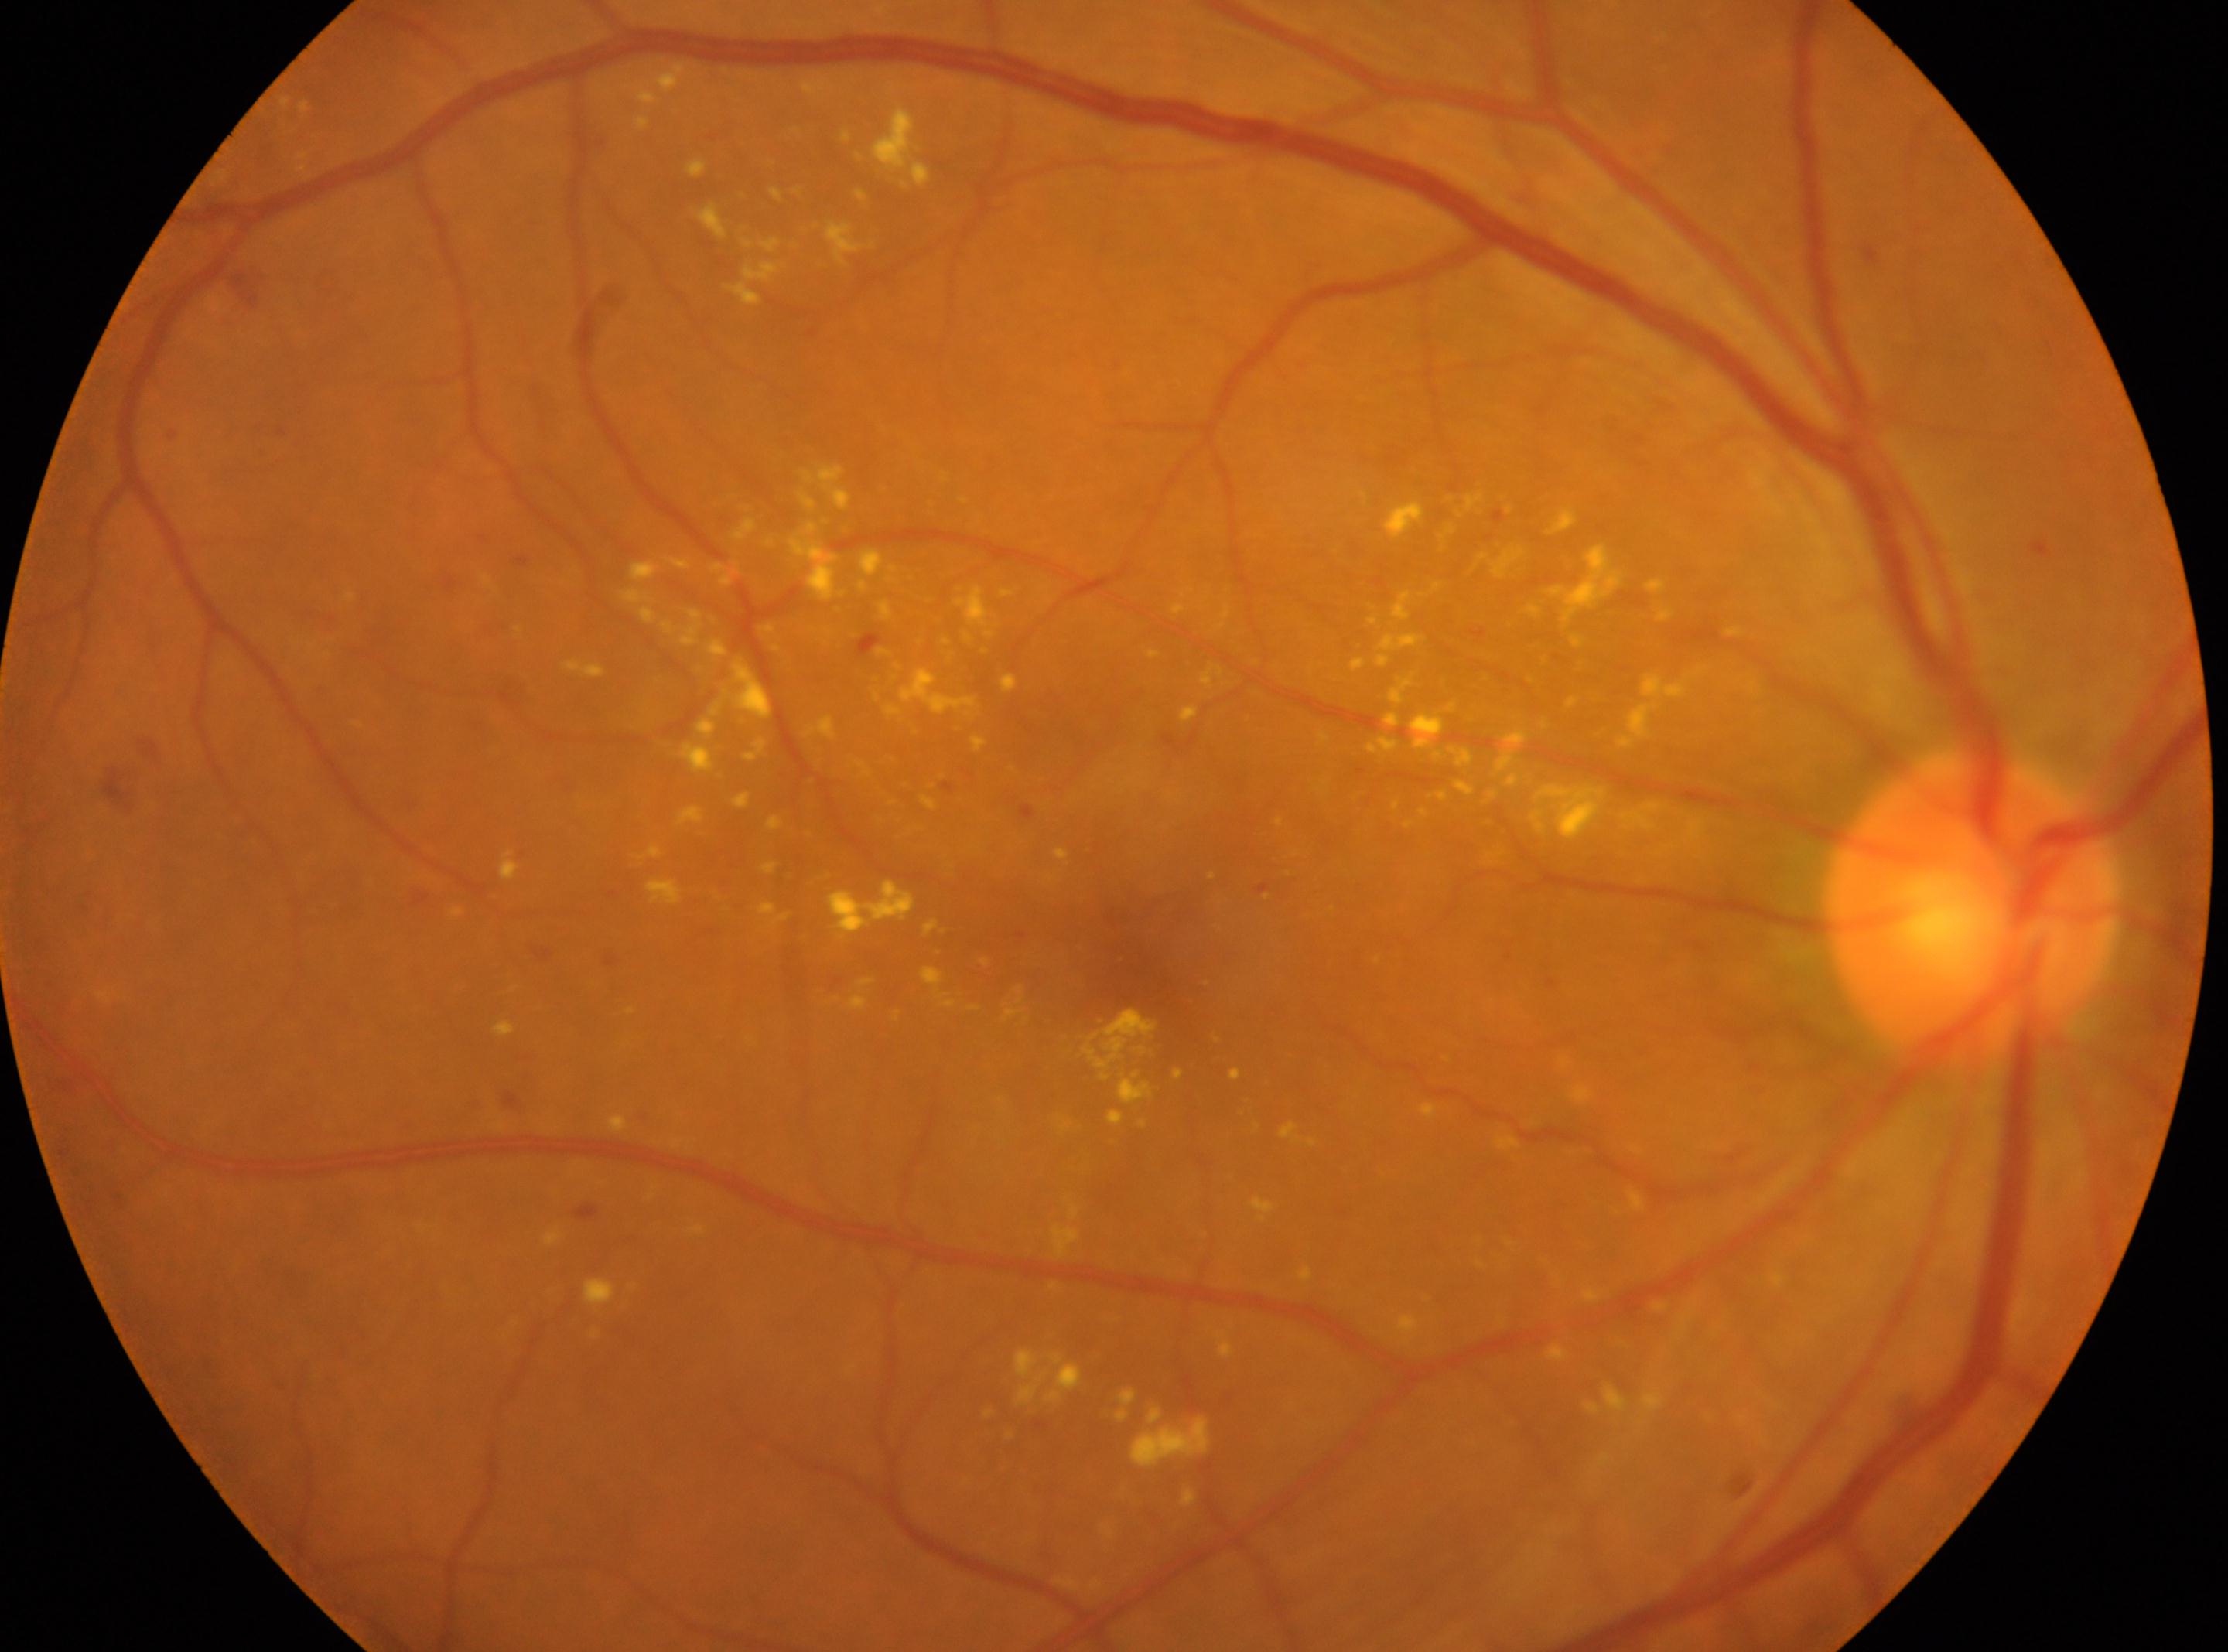

This is the right eye. Diabetic retinopathy (DR) is 2/4. Optic nerve head located at (x: 1968, y: 911). Fovea located at (x: 1131, y: 954).